Fundus photo.
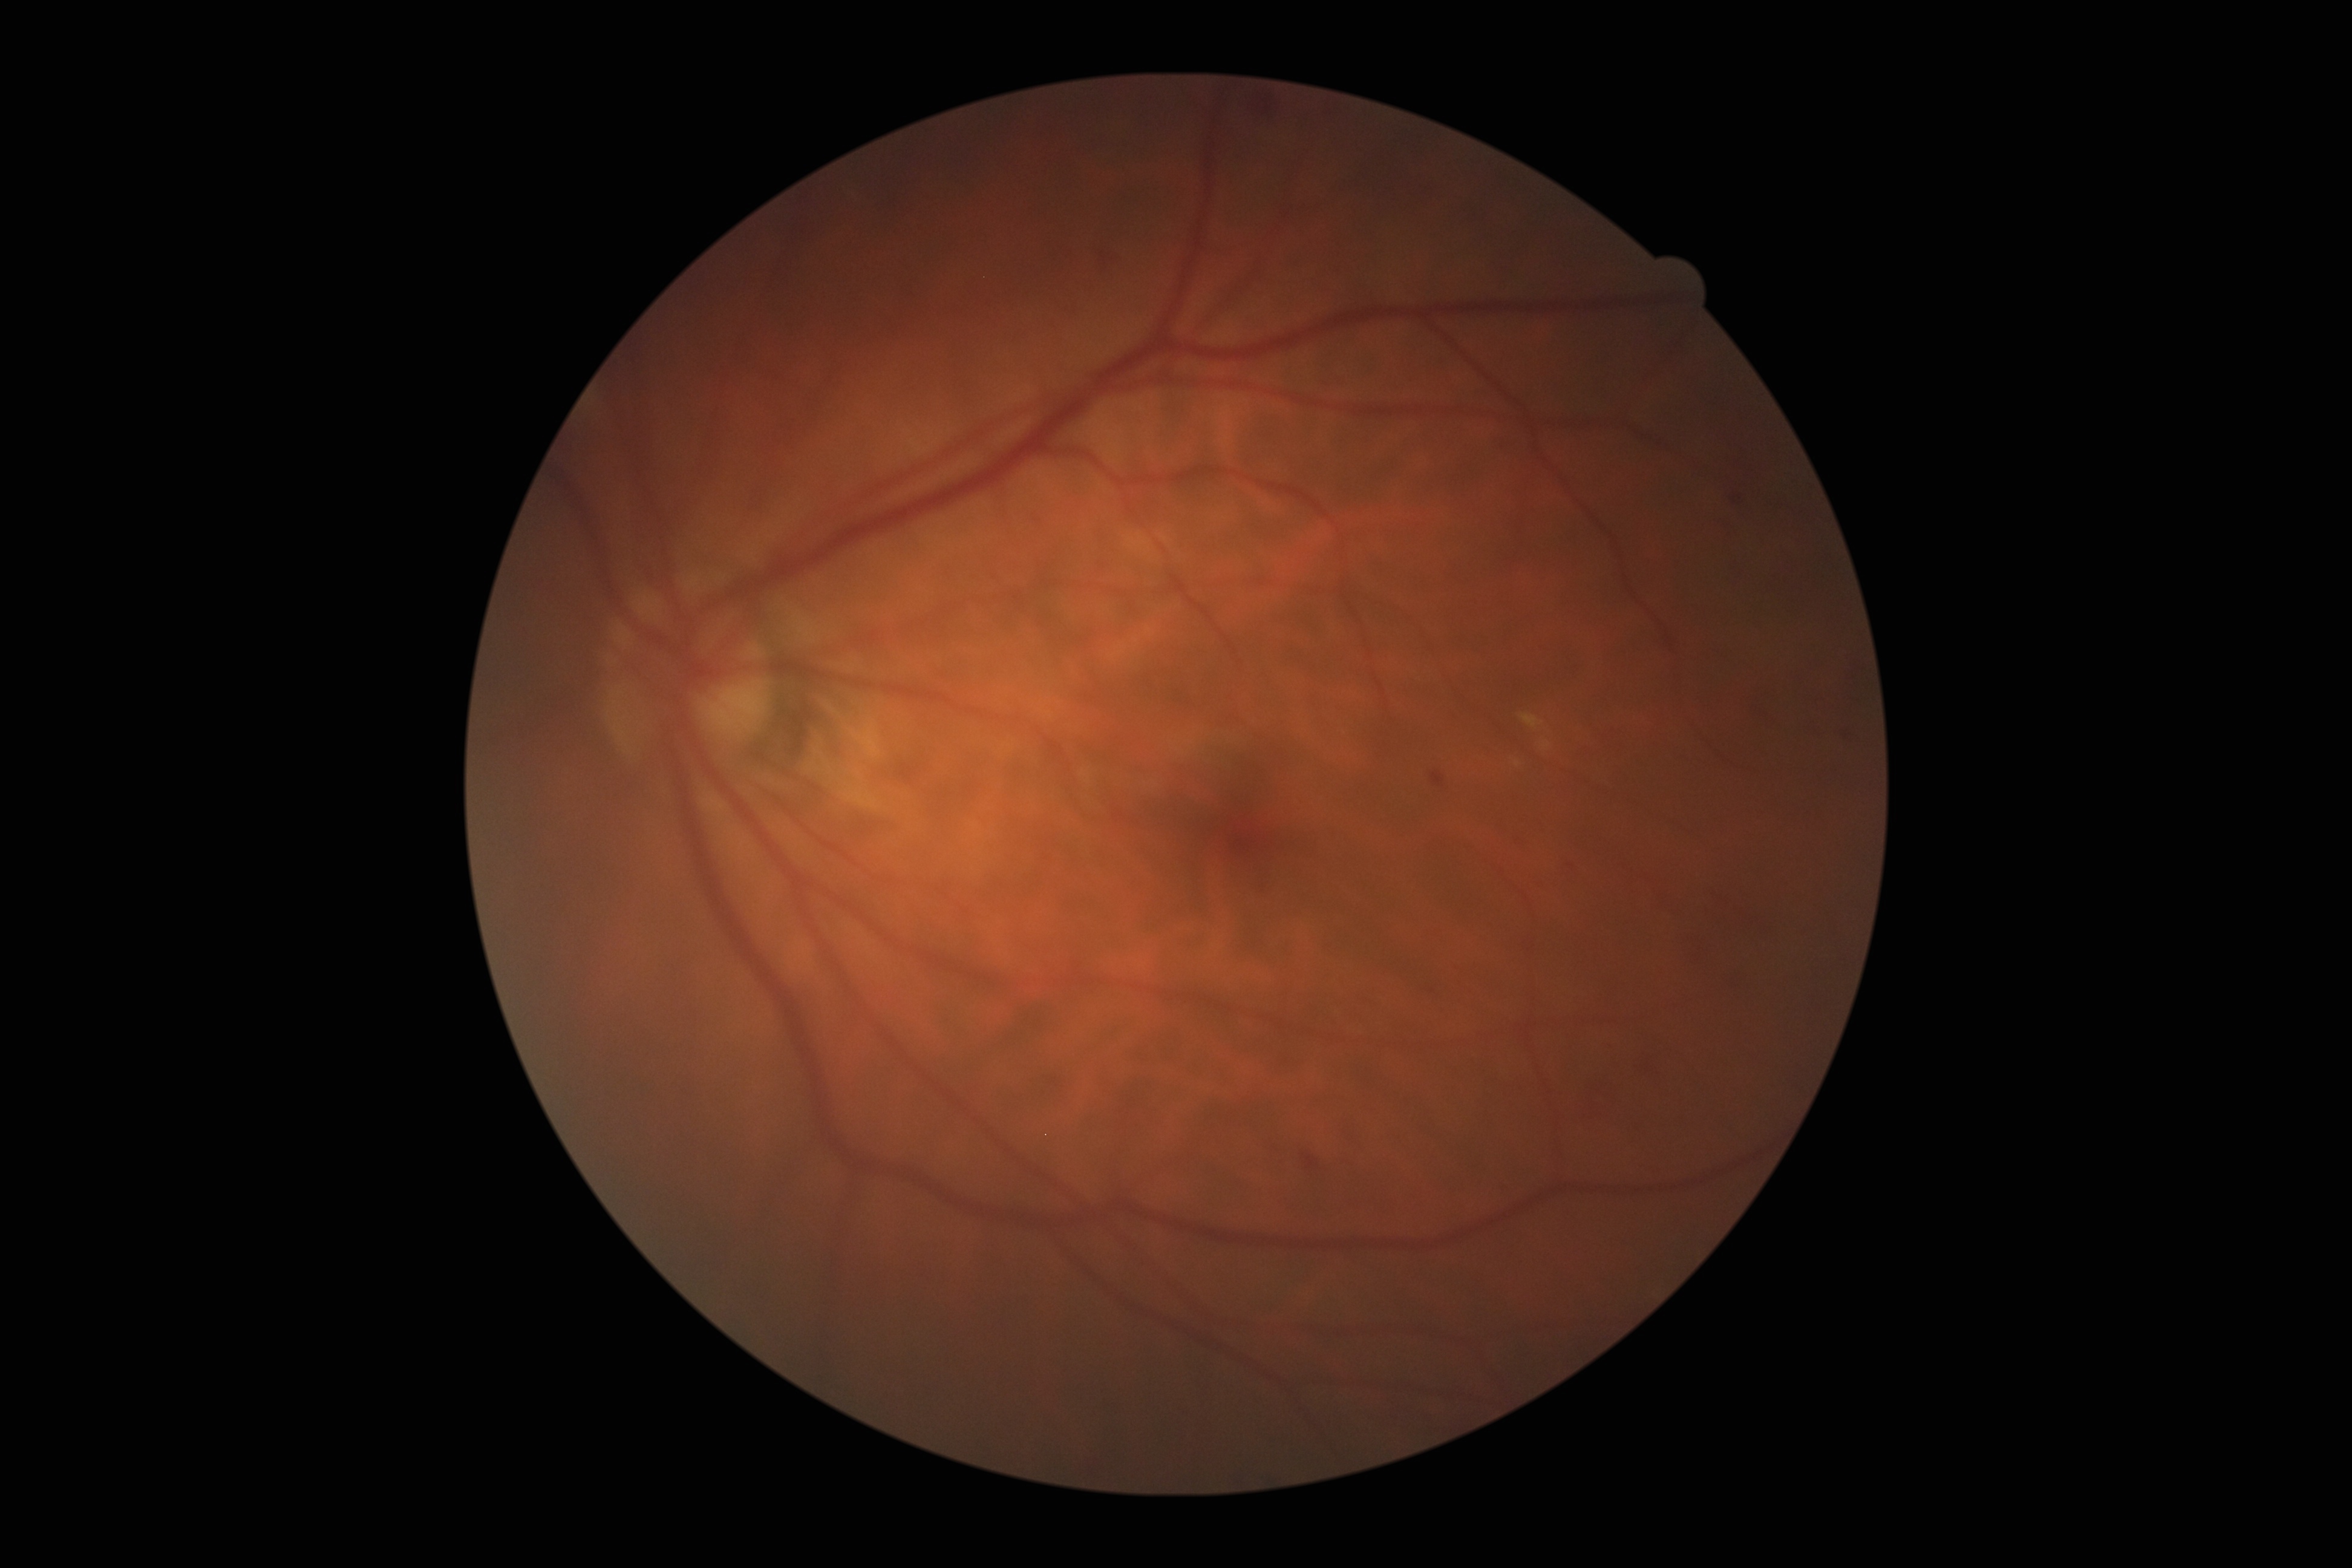

dr_grade: moderate non-proliferative diabetic retinopathy (2) — more than just microaneurysms but less than severe NPDR